2352x1568; FOV: 45 degrees: 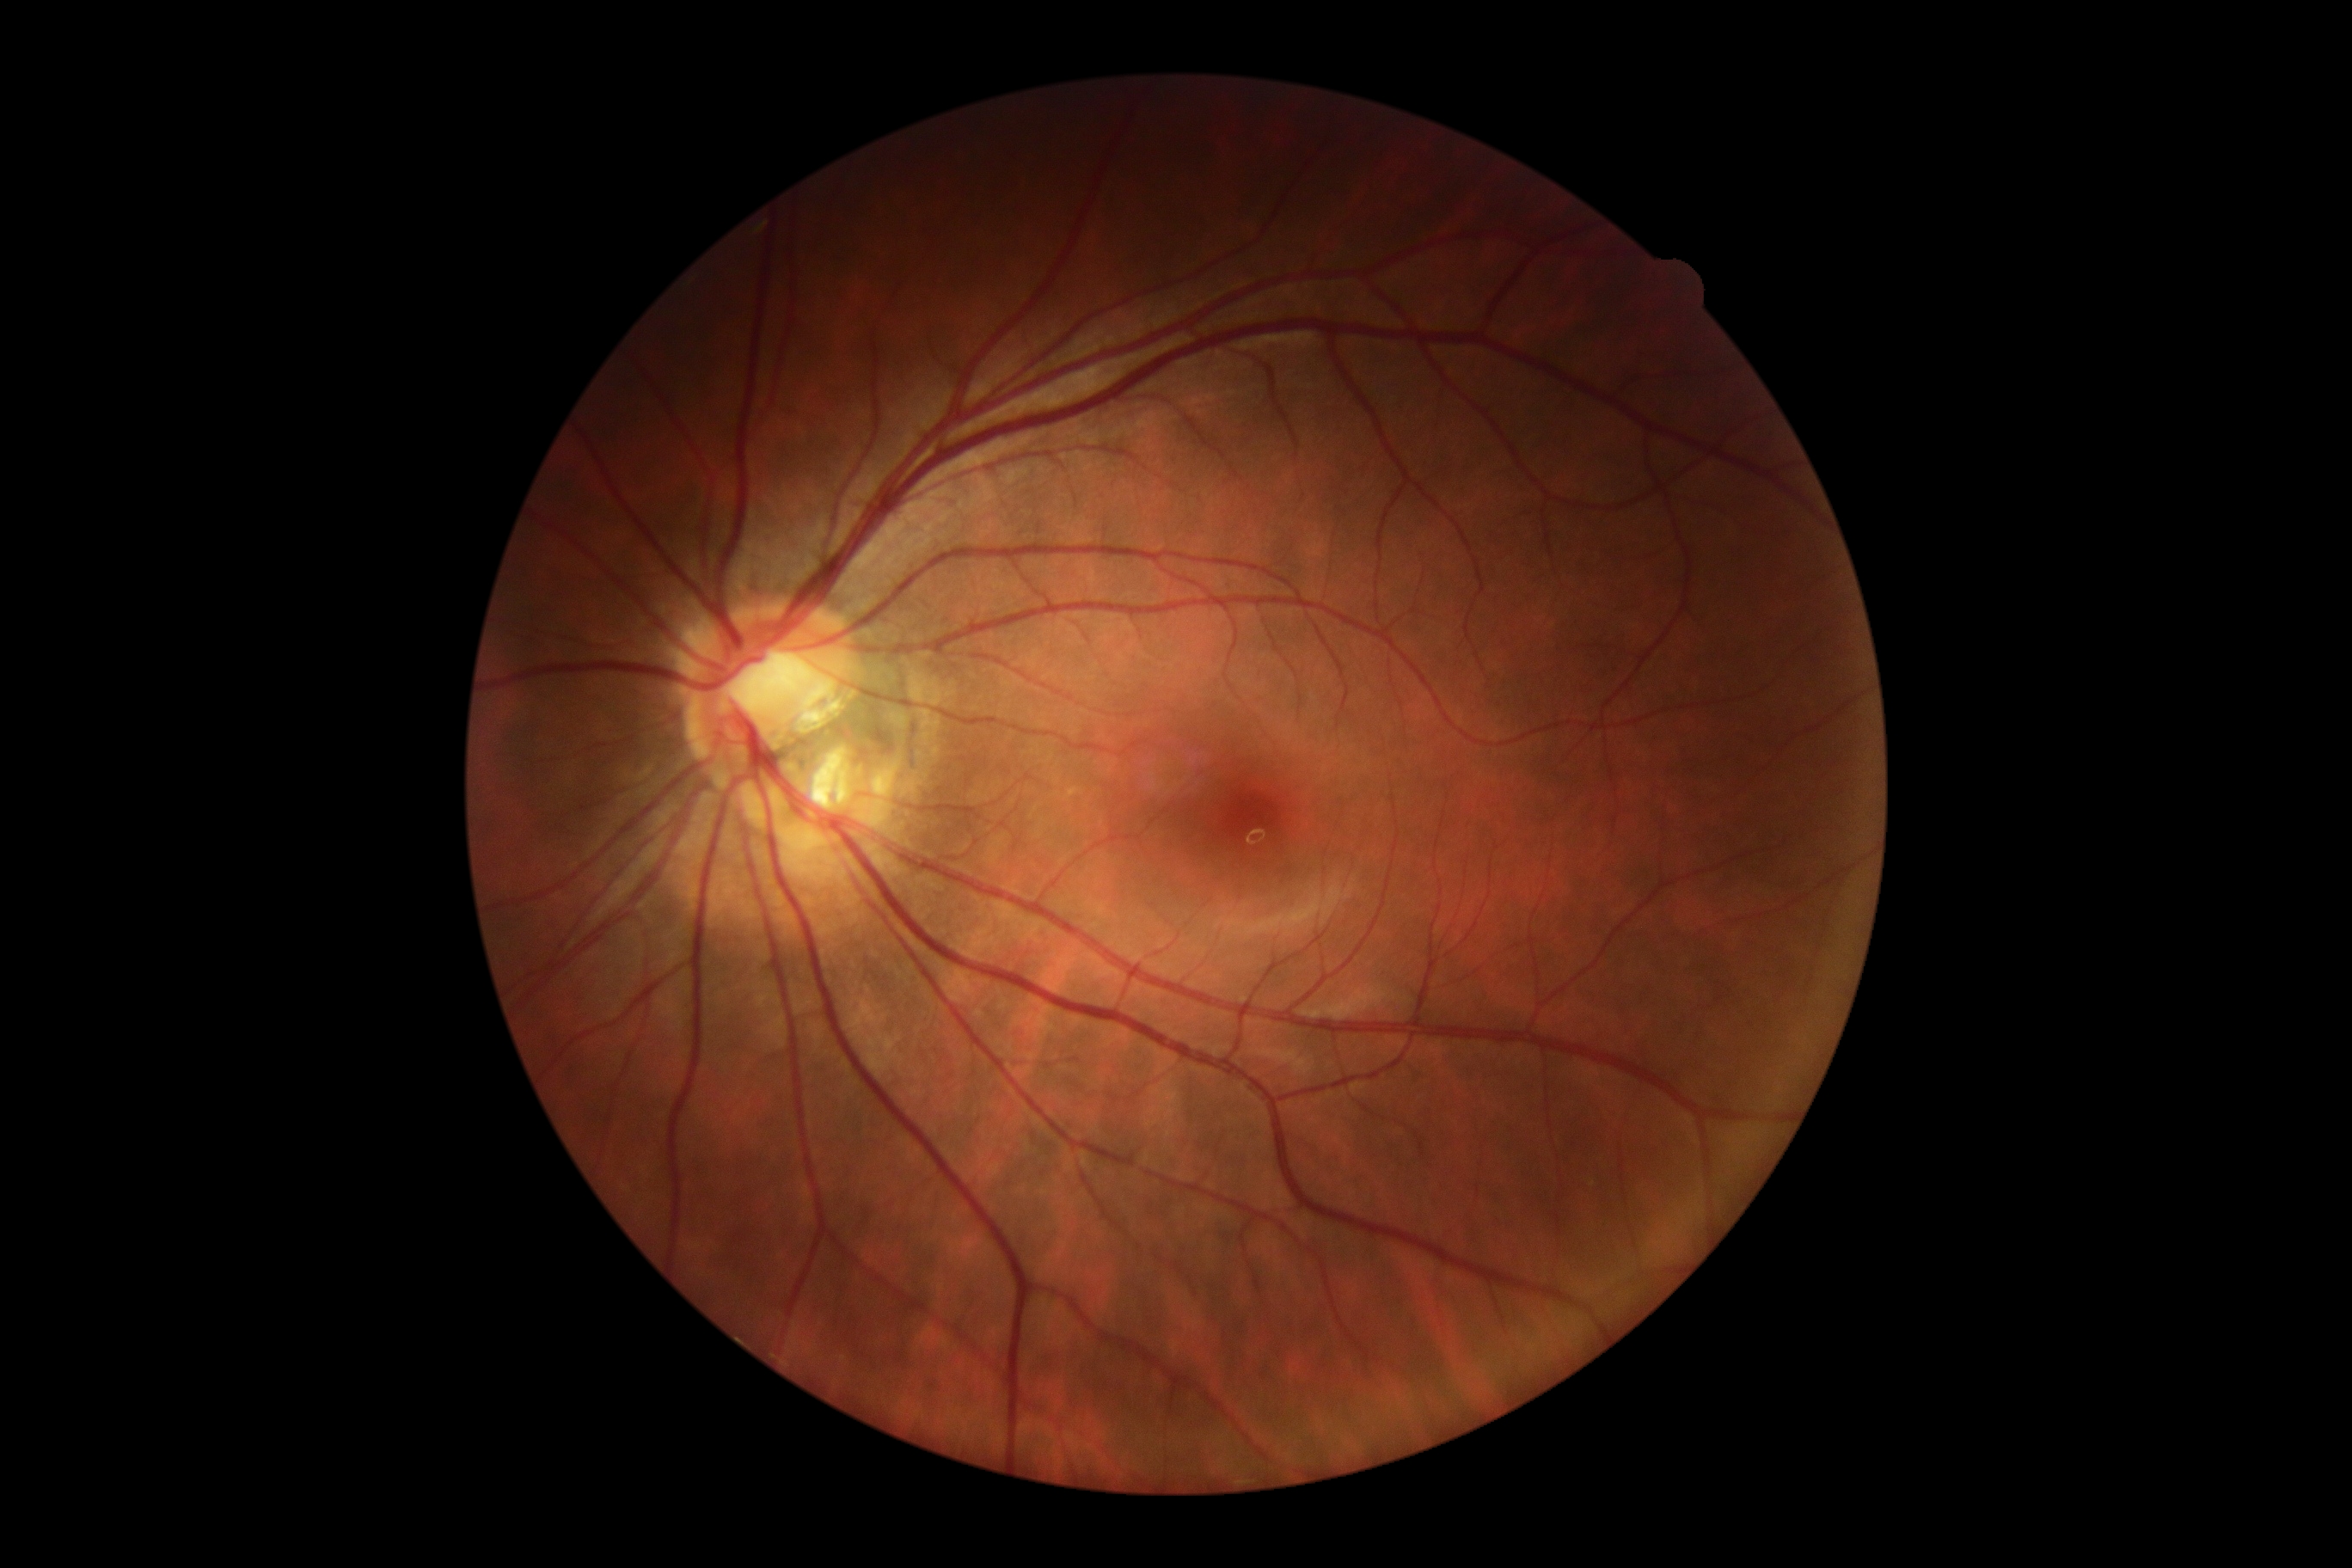

DR stage = grade 0 (no apparent retinopathy)
DR impression = no apparent DR